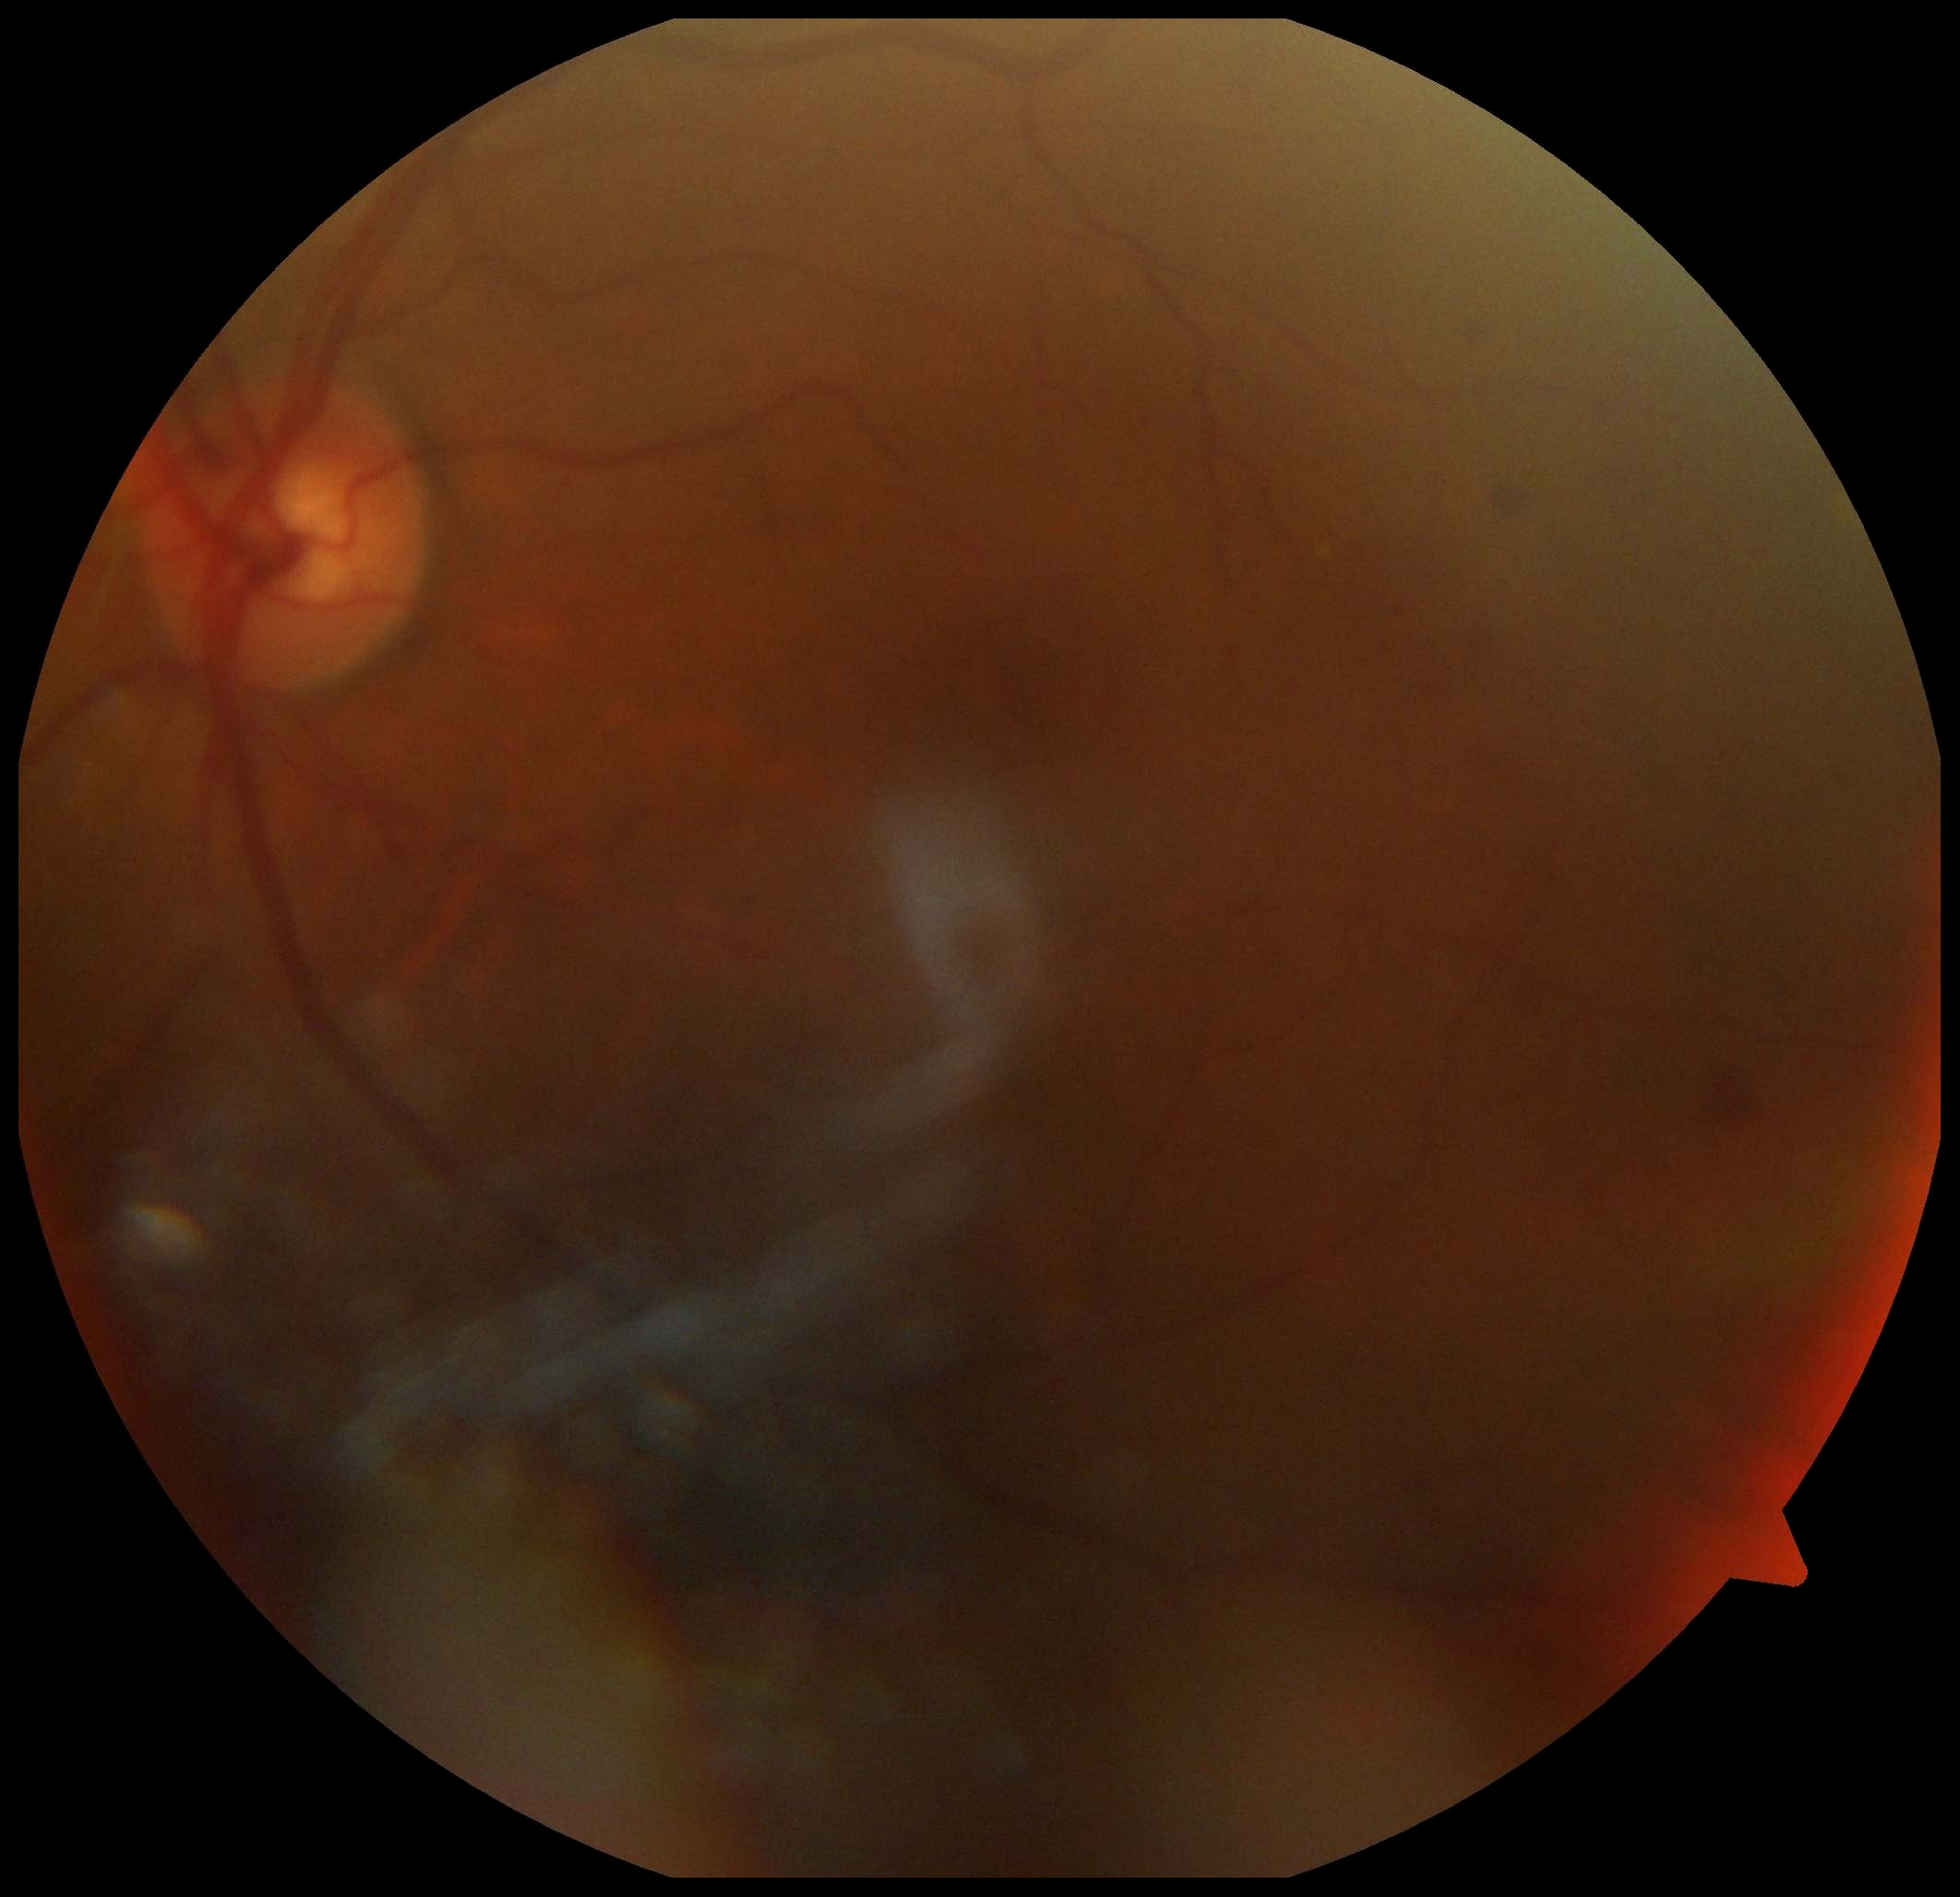
Disease class: non-proliferative diabetic retinopathy.
DR grade is moderate NPDR (2).